Wide-field fundus photograph from neonatal ROP screening; image size 640x480
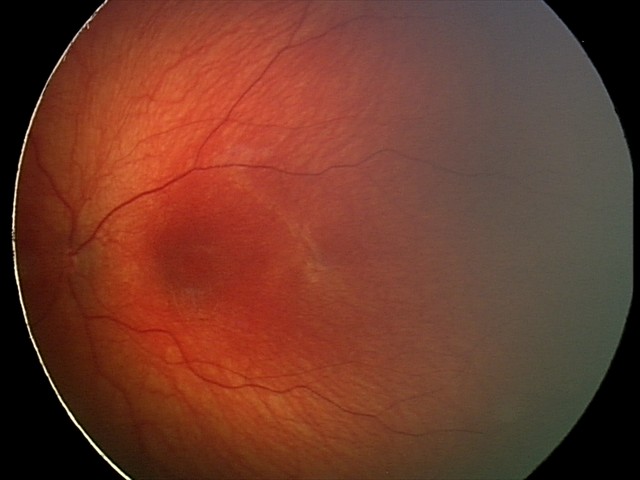
Screening diagnosis: optic nerve hypoplasia.